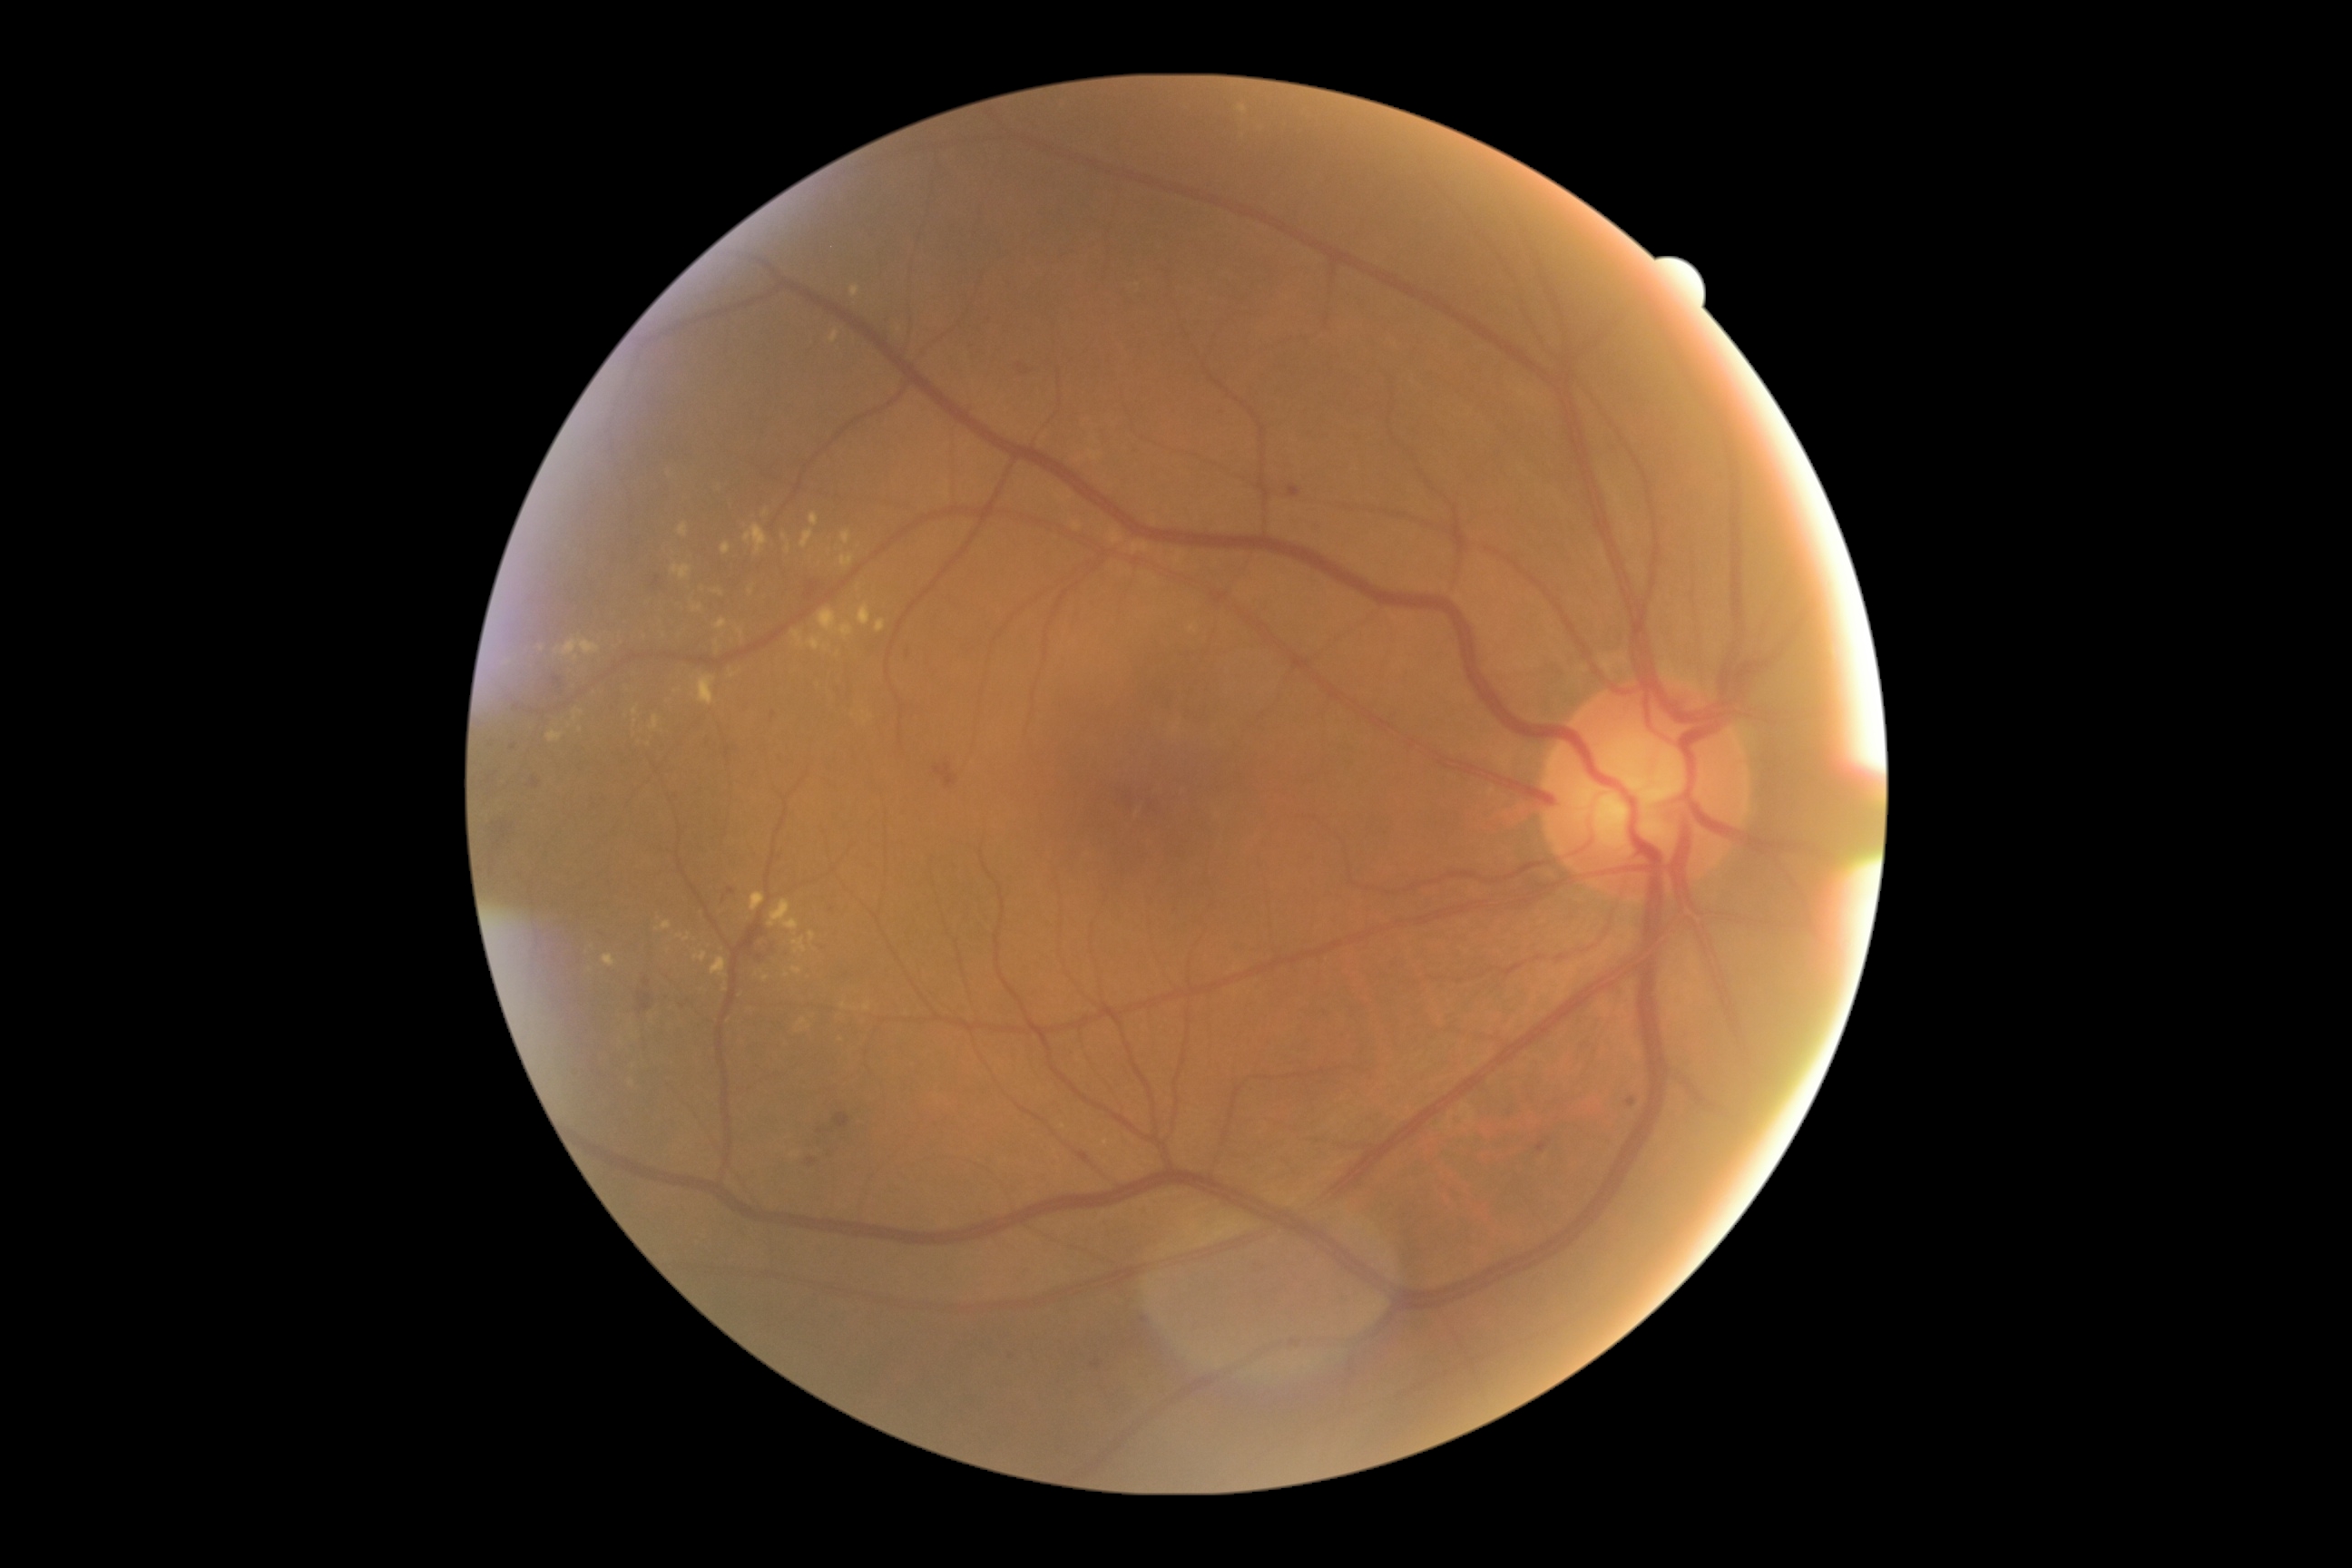

Diabetic retinopathy (DR): grade 2 (moderate NPDR)
Lesions identified (partial list):
• soft exudates (SEs): absent
• microaneurysms (MAs) (continued): x1=807 y1=1159 x2=816 y2=1166; x1=1627 y1=1099 x2=1638 y2=1108; x1=1536 y1=1142 x2=1547 y2=1153; x1=727 y1=747 x2=730 y2=758; x1=533 y1=778 x2=540 y2=789; x1=654 y1=576 x2=660 y2=587; x1=1289 y1=485 x2=1302 y2=498
• Small MAs approximately at (683,1006); (821,1132); (774,715); (1144,1319); (513,746); (832,910); (908,654)
• hard exudates (EXs) (continued): x1=714 y1=591 x2=723 y2=596; x1=603 y1=956 x2=616 y2=968; x1=769 y1=901 x2=799 y2=932; x1=694 y1=952 x2=709 y2=963; x1=792 y1=631 x2=821 y2=651; x1=876 y1=620 x2=887 y2=632; x1=750 y1=894 x2=765 y2=912; x1=810 y1=513 x2=819 y2=525; x1=712 y1=957 x2=727 y2=979; x1=839 y1=625 x2=854 y2=640; x1=792 y1=968 x2=803 y2=974; x1=798 y1=1019 x2=807 y2=1026
• Small EXs approximately at (669,474); (865,714); (825,648); (733,676); (697,608); (766,513)
• hemorrhages (HEs): x1=1092 y1=1360 x2=1102 y2=1369; x1=729 y1=888 x2=736 y2=896; x1=553 y1=674 x2=564 y2=696; x1=934 y1=765 x2=959 y2=789; x1=805 y1=582 x2=821 y2=603; x1=1019 y1=364 x2=1023 y2=373; x1=480 y1=774 x2=491 y2=792; x1=638 y1=992 x2=652 y2=1014; x1=834 y1=1113 x2=852 y2=1130; x1=493 y1=823 x2=509 y2=847; x1=741 y1=928 x2=767 y2=957
• Small HEs approximately at (758,958); (648,983); (1028,372)